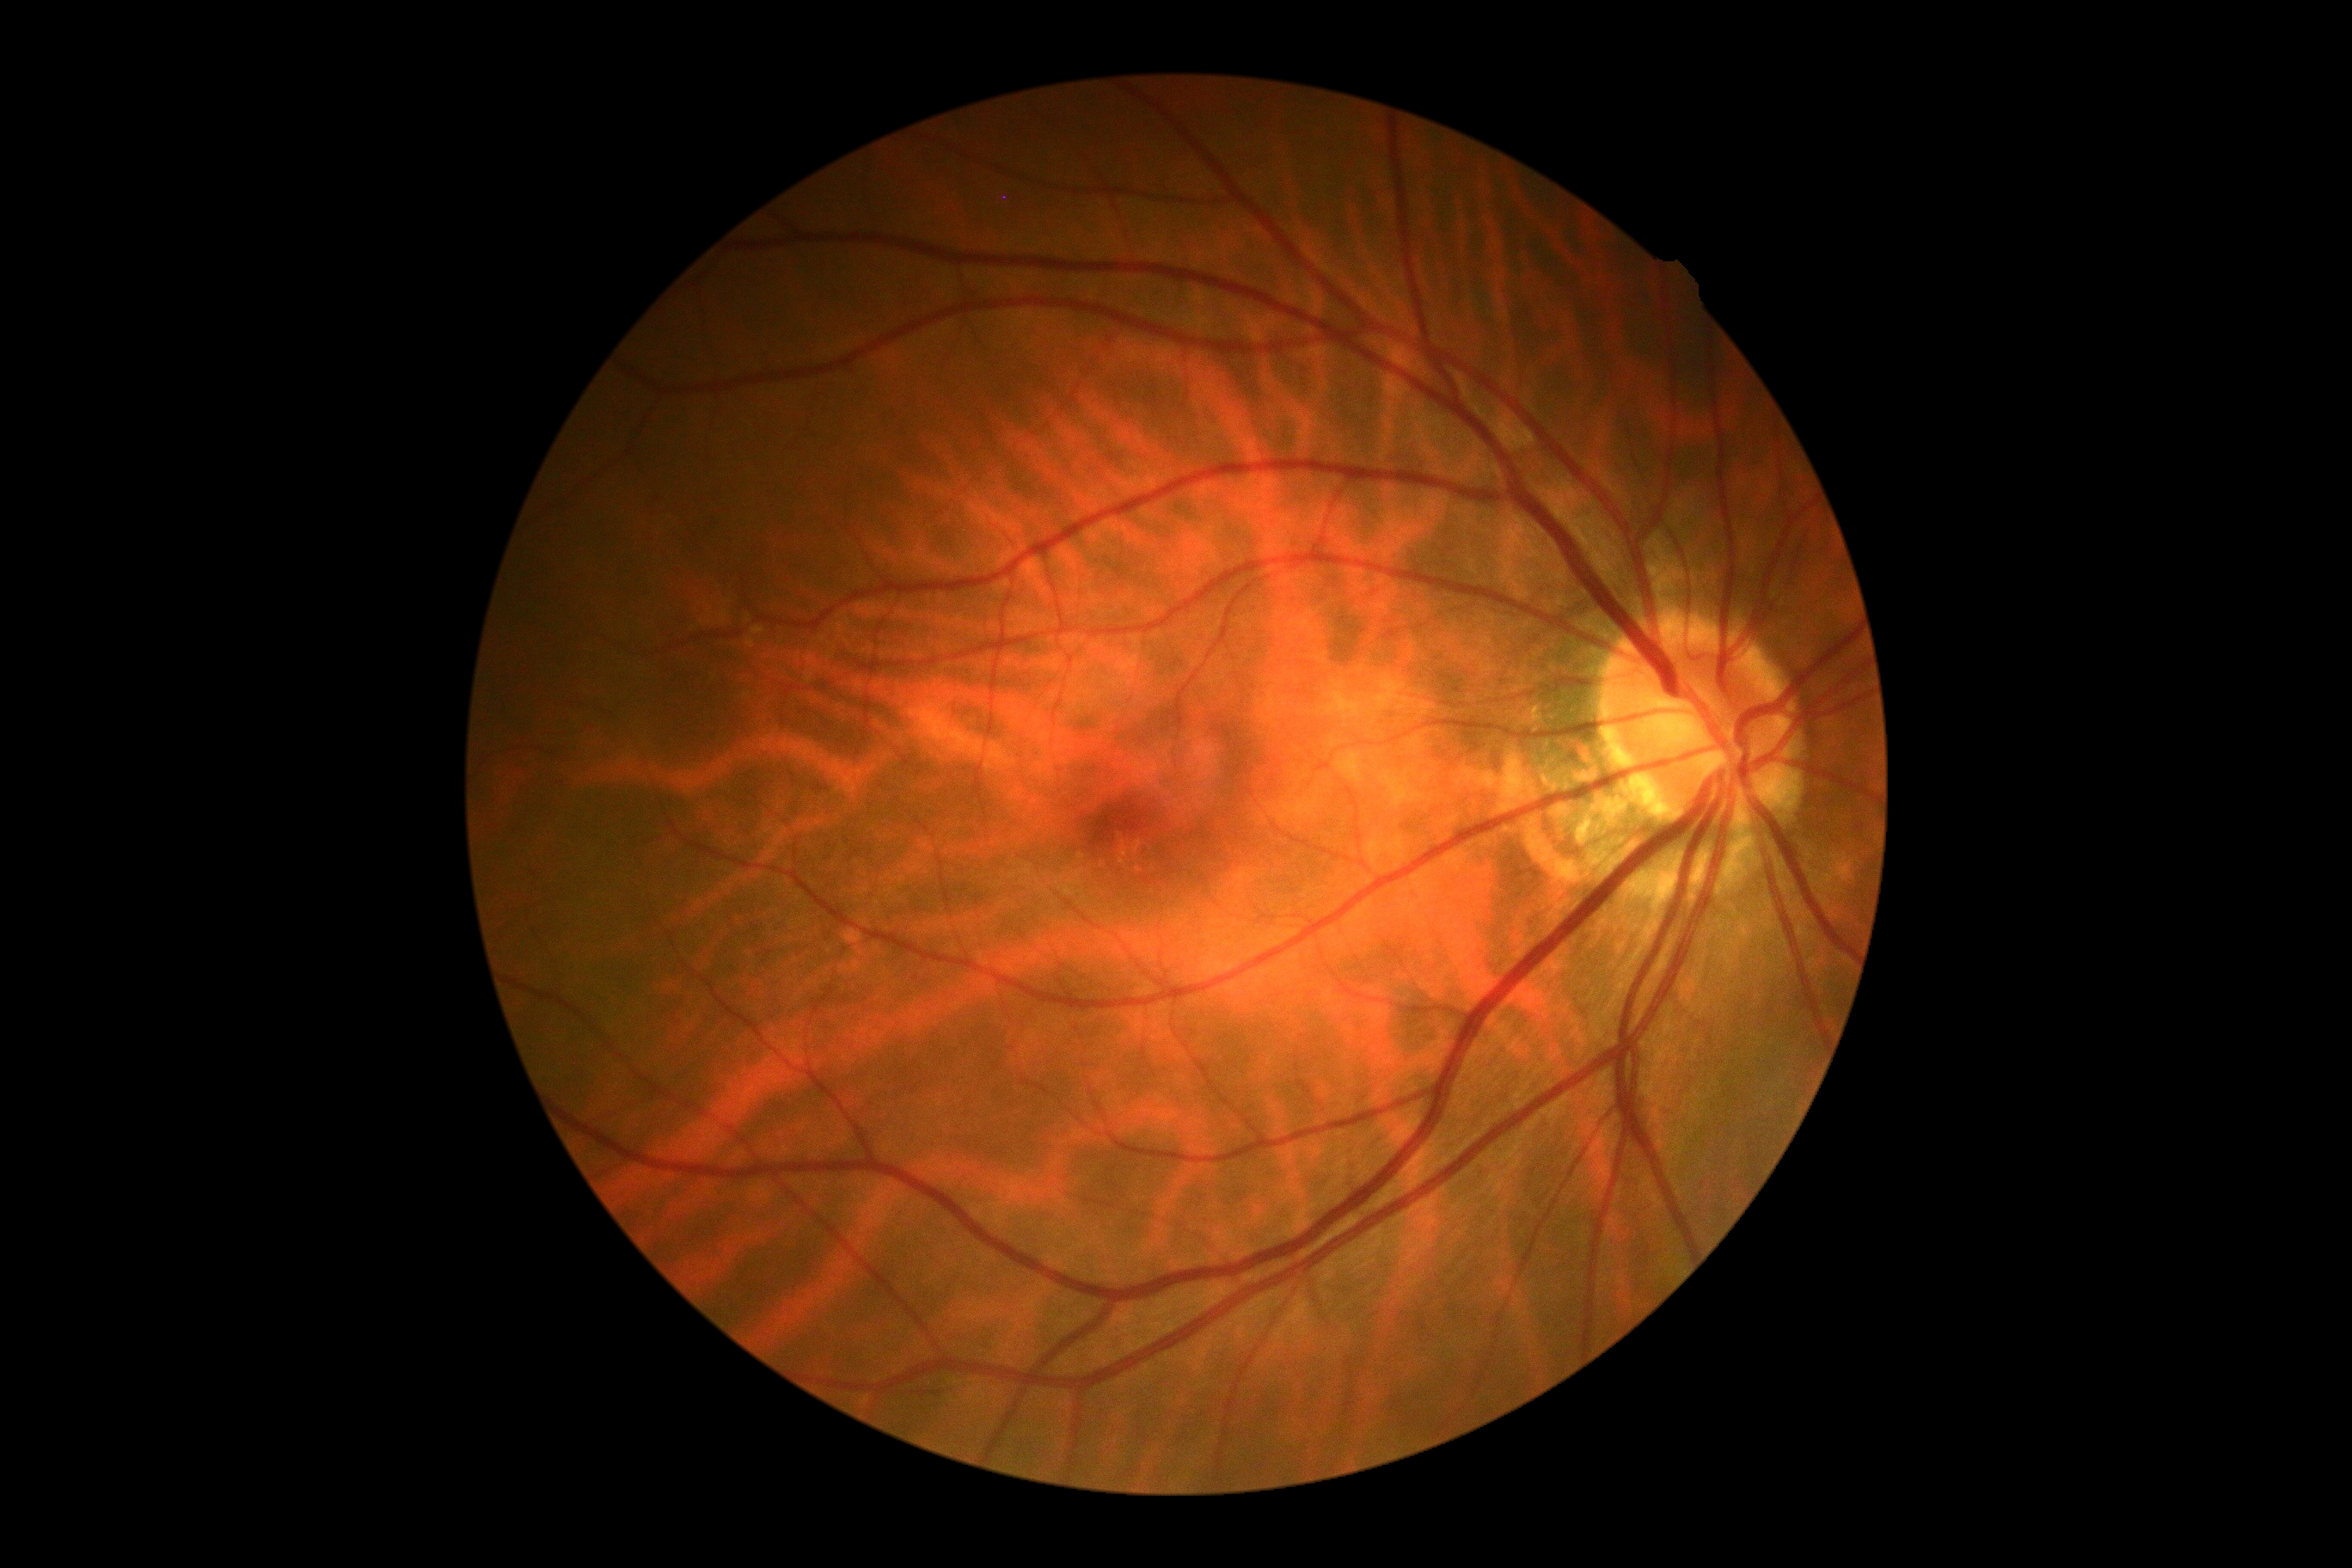 retinopathy=grade 0 (no apparent retinopathy).